Nonmydriatic: 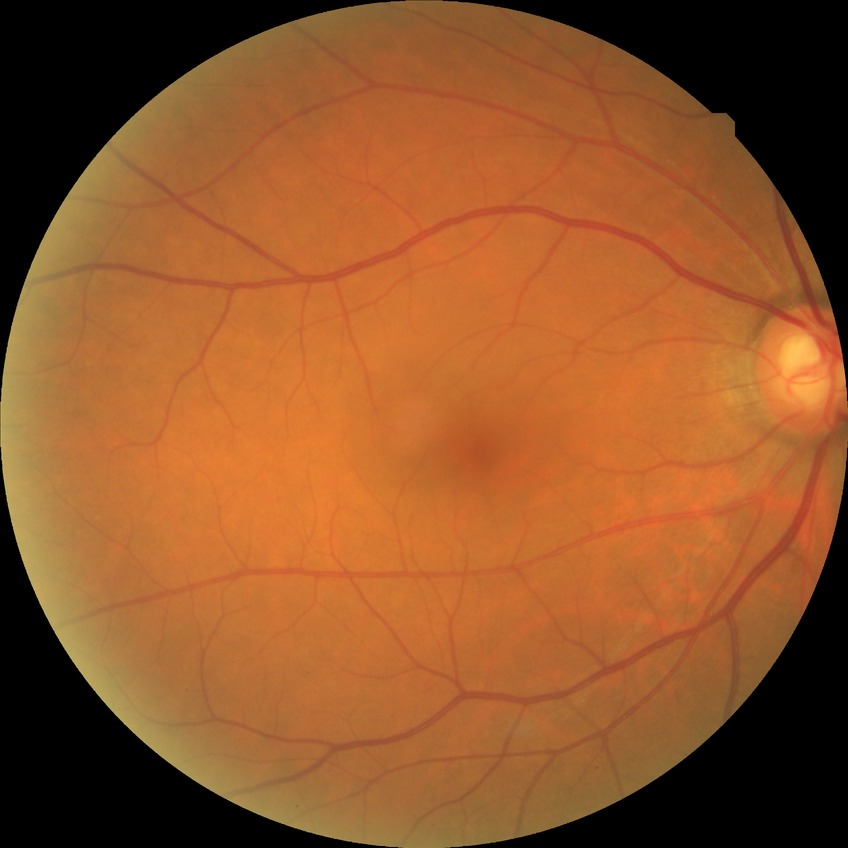
Findings:
• retinopathy grade — no diabetic retinopathy